2048x1536 — 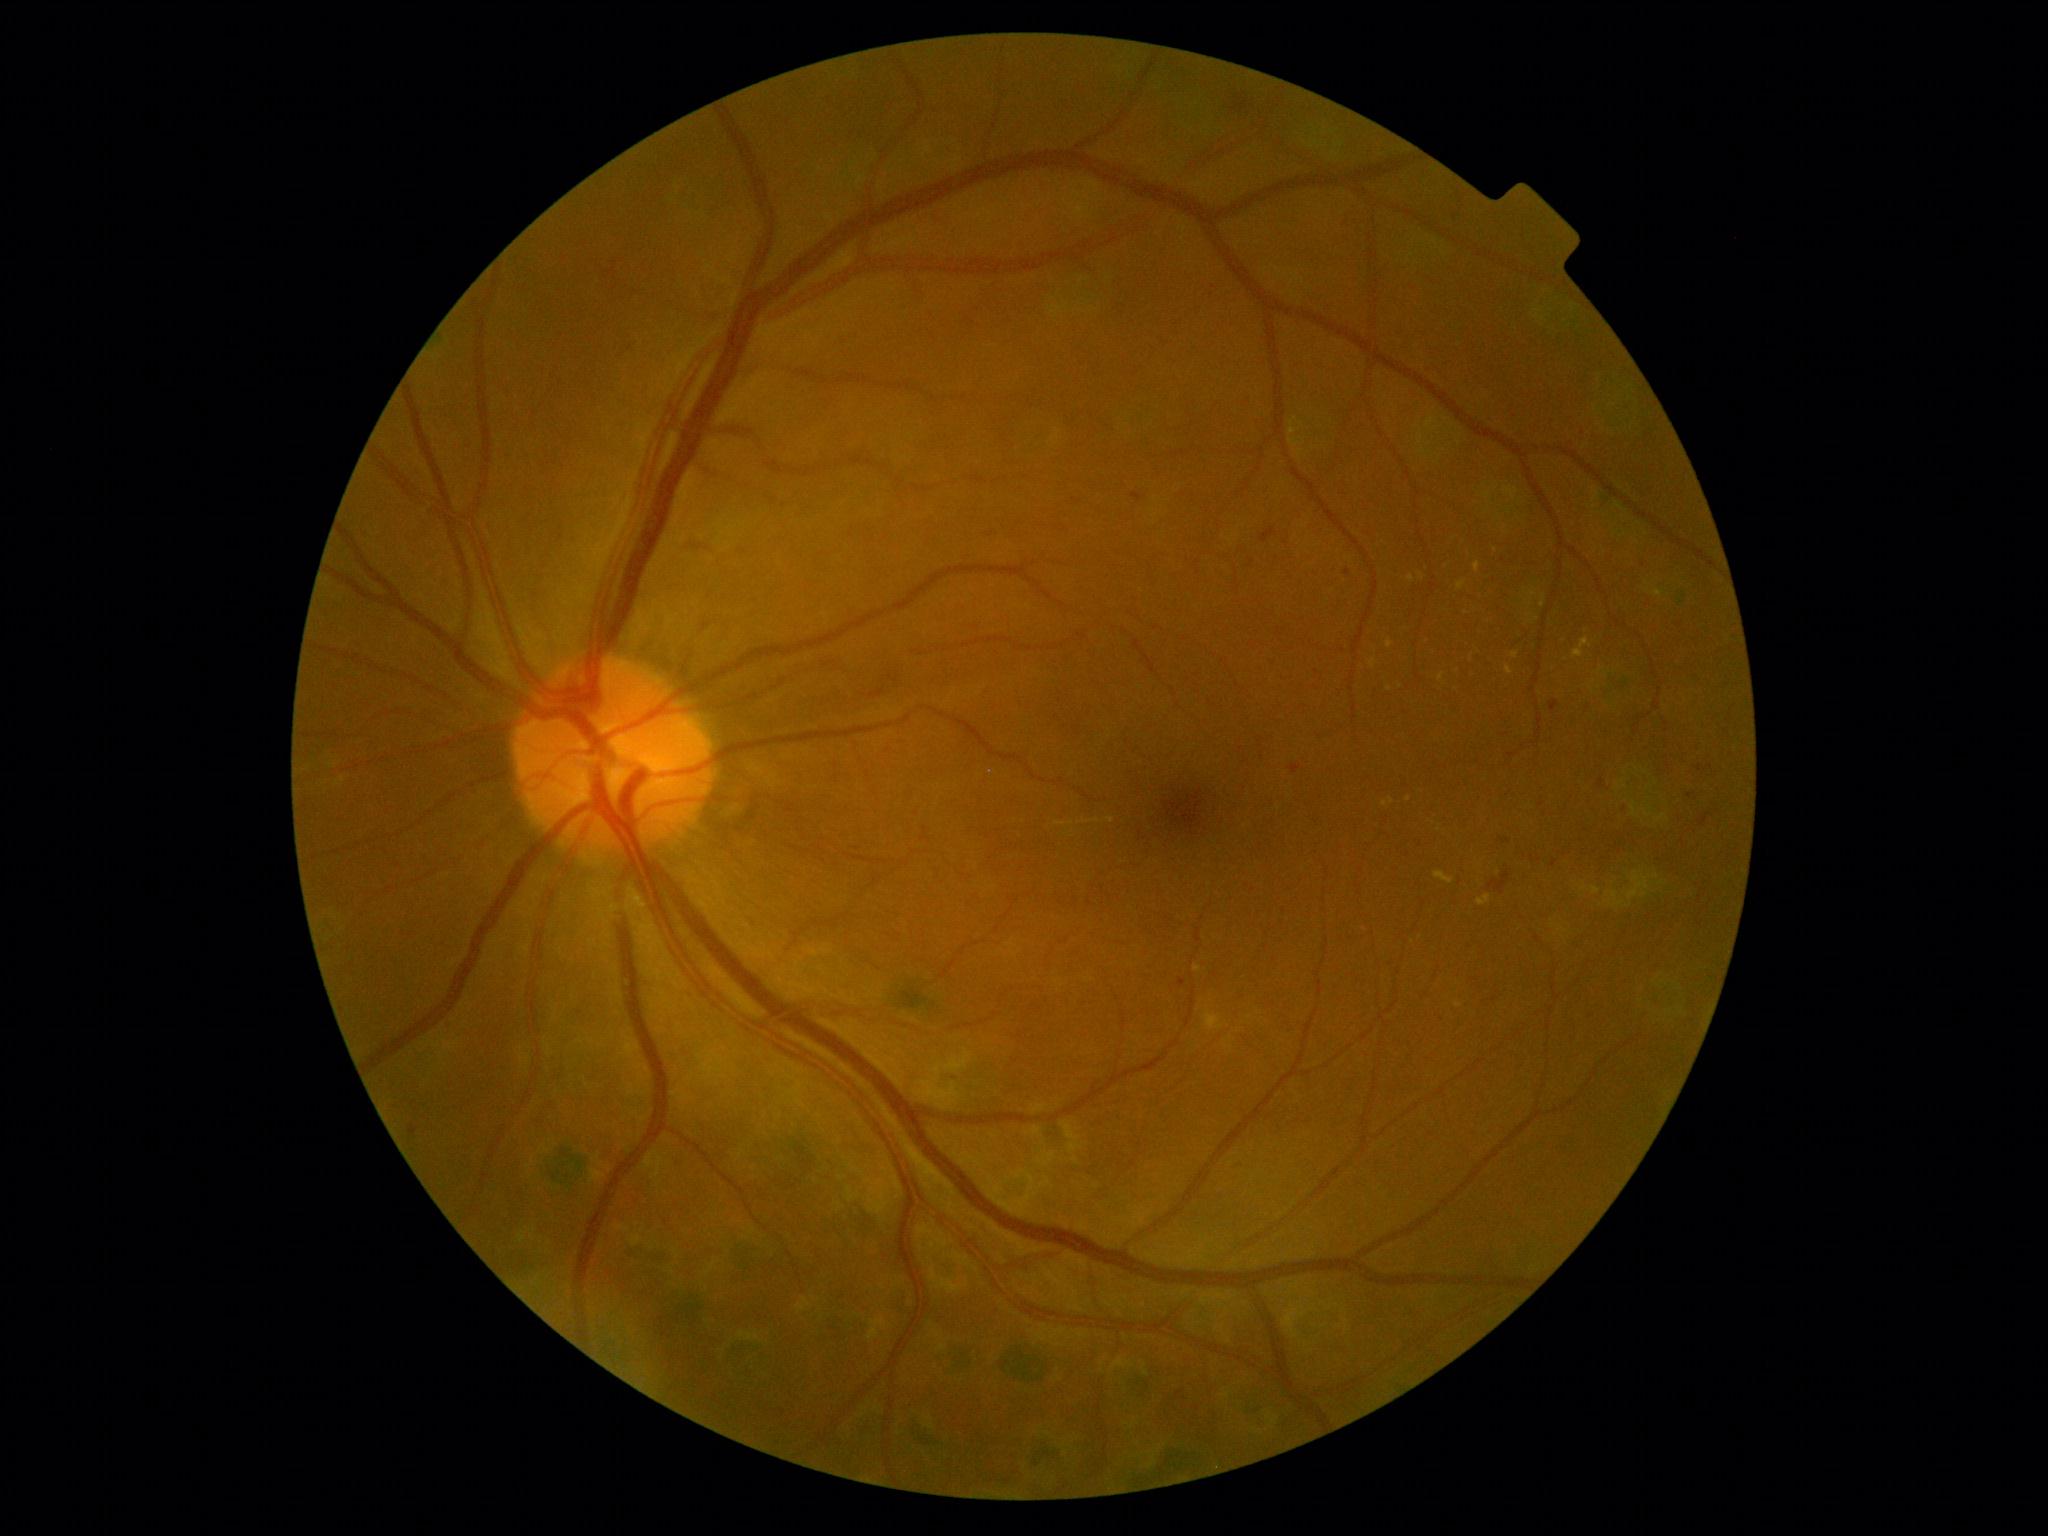 {"partial":true,"dr_grade":2,"dr_grade_name":"moderate NPDR","lesions":{"ex":[[1573,637,1592,659],[1477,895,1492,906],[1457,580,1467,591],[1370,659,1377,669],[1194,965,1202,972],[1439,673,1444,682],[1506,666,1513,674]],"ex_small":[[1409,799],[1471,660],[1459,1005],[1390,689],[1097,821]]}}